45° field of view.
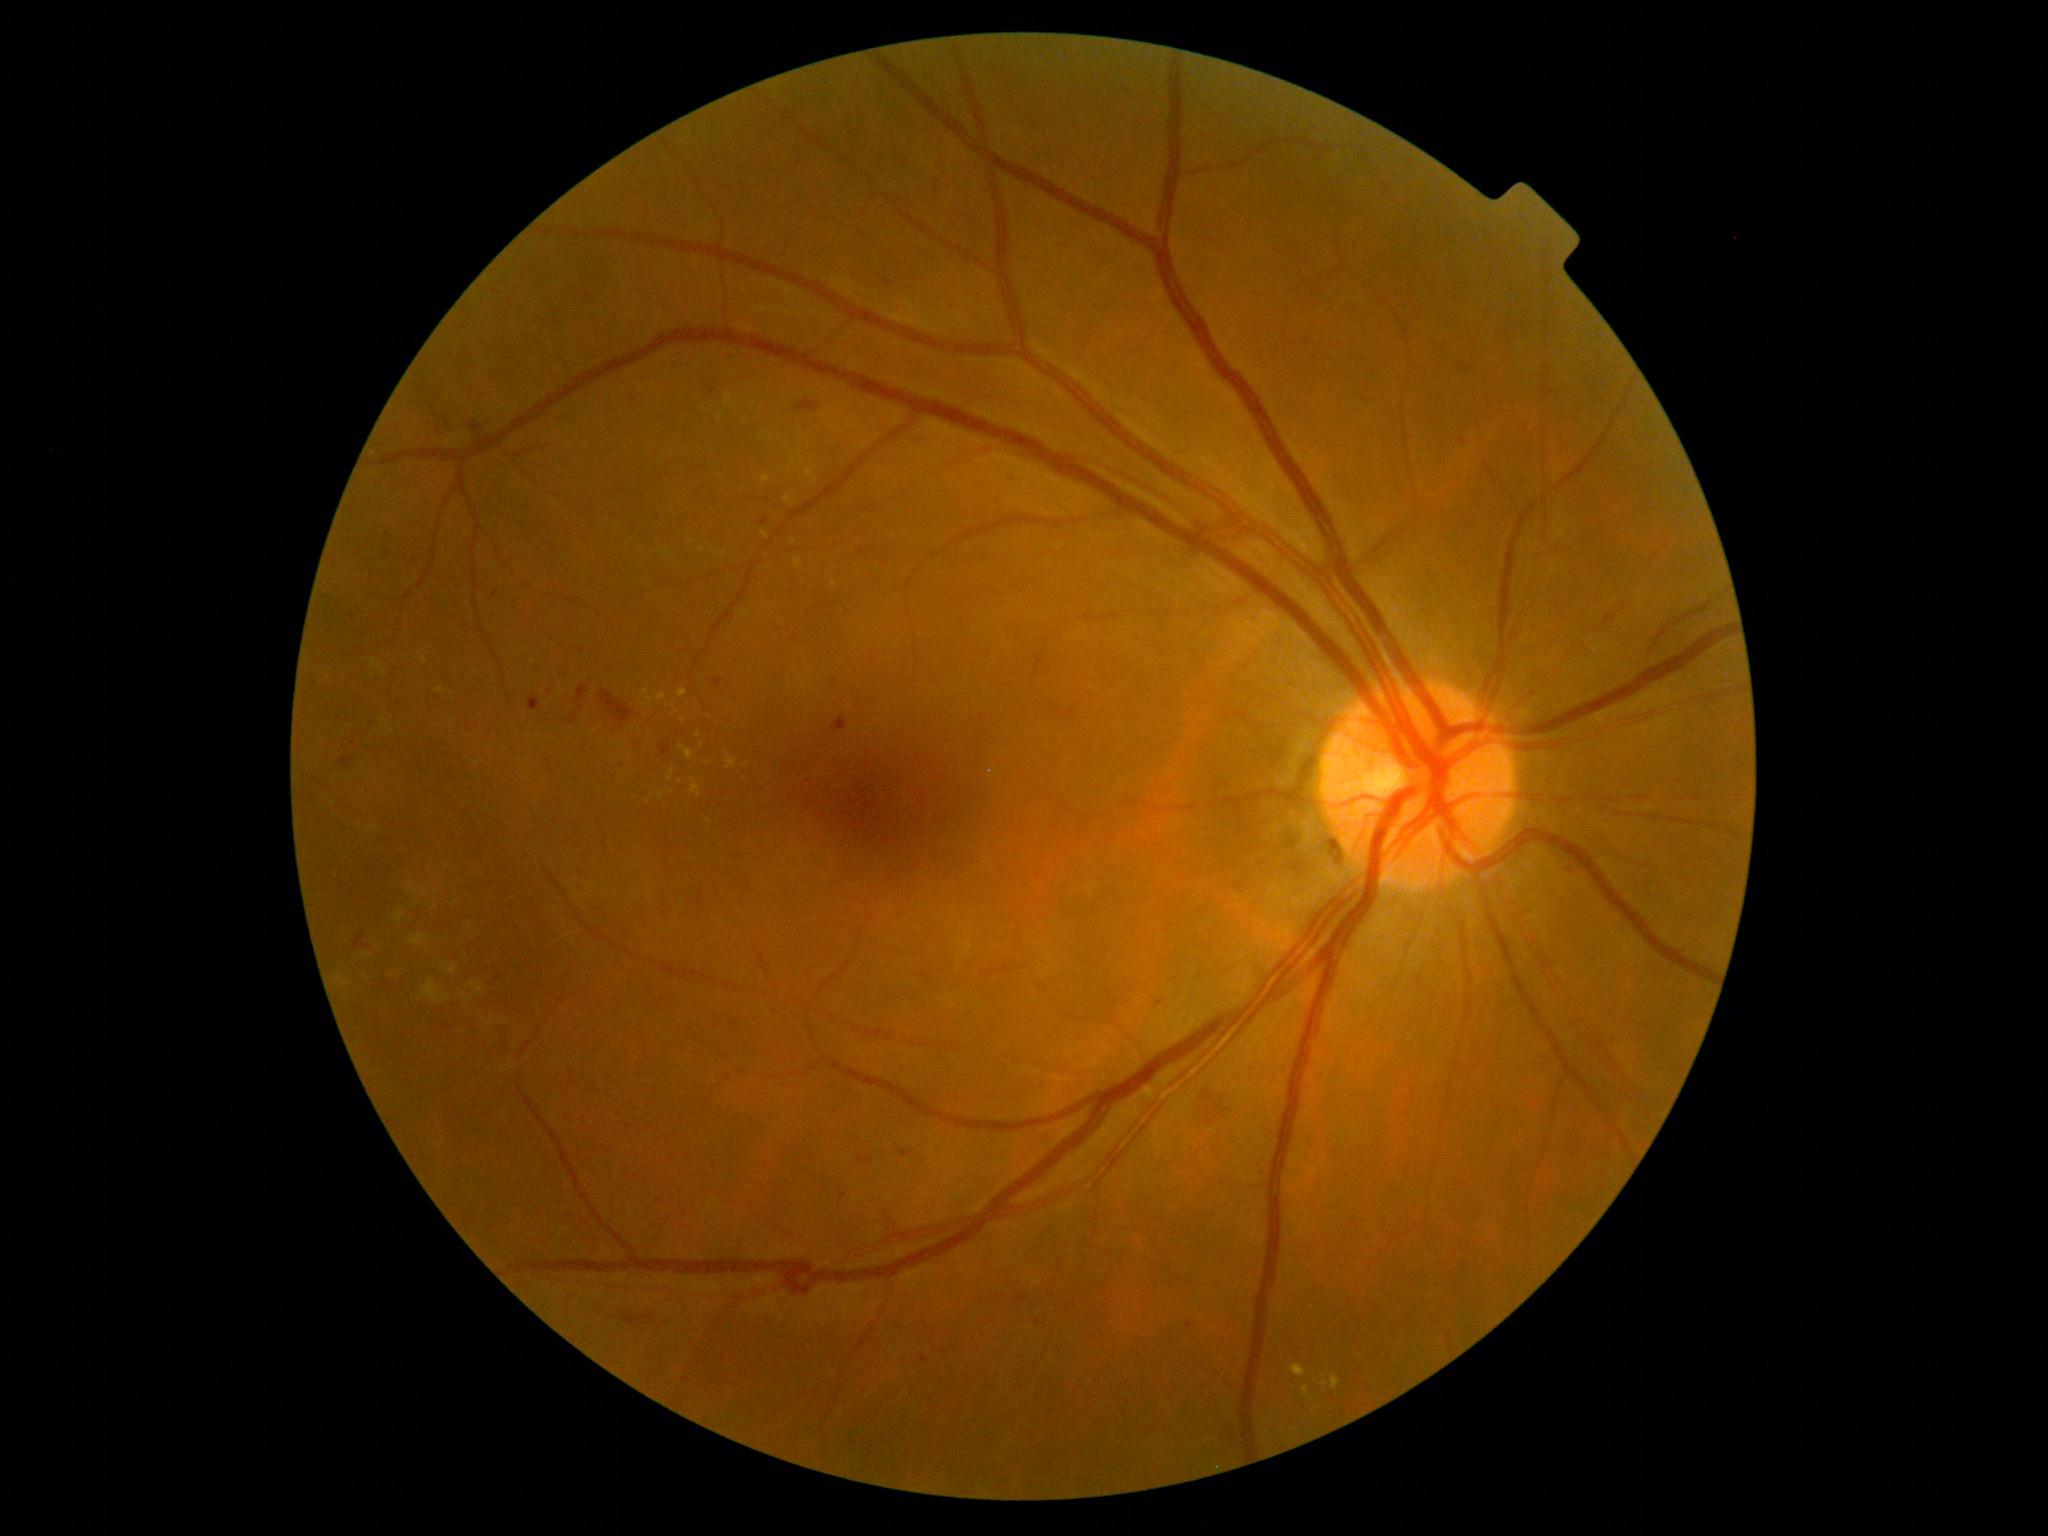
DR severity is moderate NPDR (grade 2)
Selected lesions:
SEs: none identified
EXs (more not shown): BBox(1331, 1376, 1341, 1389) | BBox(679, 689, 688, 697) | BBox(795, 558, 802, 569) | BBox(668, 769, 675, 782) | BBox(805, 465, 817, 478) | BBox(762, 475, 771, 484) | BBox(691, 778, 702, 798)
EXs (small, approximate centers) near 424/660 | 815/481 | 648/801 | 661/796 | 680/781 | 698/736 | 646/692 | 794/462 | 1324/1383 | 703/745
HEs: BBox(795, 399, 817, 414) | BBox(355, 934, 365, 949) | BBox(1229, 1425, 1237, 1449) | BBox(860, 1155, 871, 1164) | BBox(566, 712, 577, 725) | BBox(599, 690, 635, 726) | BBox(621, 1312, 641, 1324) | BBox(706, 385, 714, 395) | BBox(340, 756, 354, 769) | BBox(576, 686, 589, 710) | BBox(831, 717, 848, 732) | BBox(1194, 1088, 1228, 1130)
MAs: BBox(529, 697, 539, 706) | BBox(1186, 1322, 1194, 1329) | BBox(714, 679, 722, 689) | BBox(901, 1150, 911, 1157) | BBox(1020, 1294, 1029, 1299) | BBox(857, 548, 865, 556) | BBox(659, 743, 671, 756)
MAs (small, approximate centers) near 620/763 | 1462/442 | 1039/1323 | 1160/1003 | 658/517 | 842/1196 | 495/594 | 1052/1295 | 414/563 | 390/535 | 924/1359 | 388/555